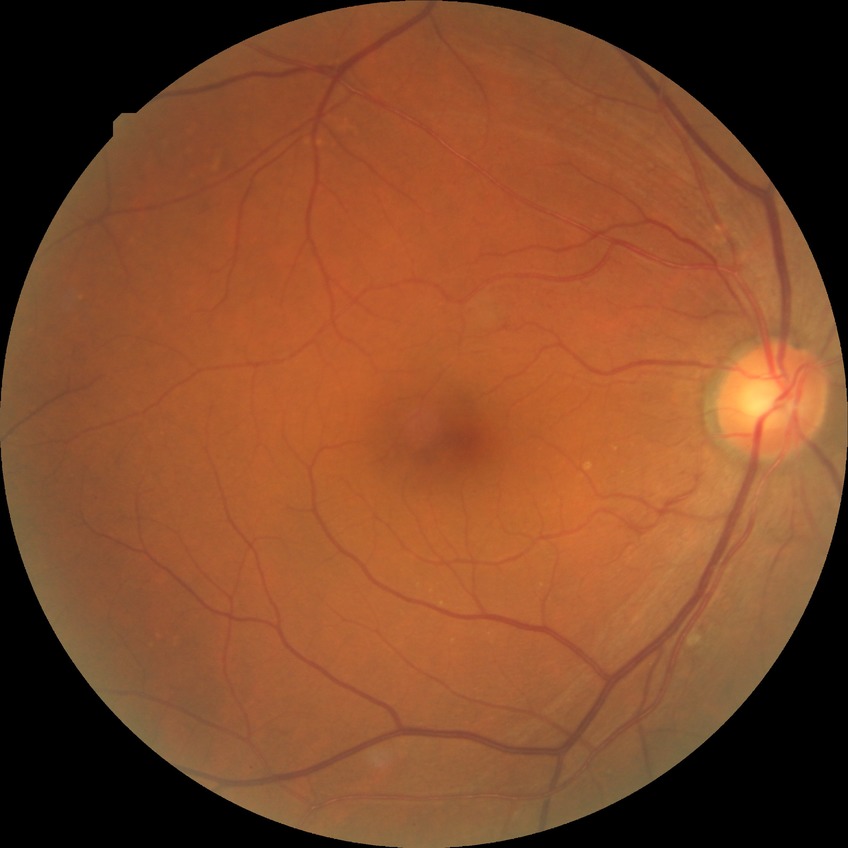 {
  "davis_grade": "NDR (no diabetic retinopathy)"
}